Image size 367x367. Mydriatic. Fundus image cropped to the optic disc:
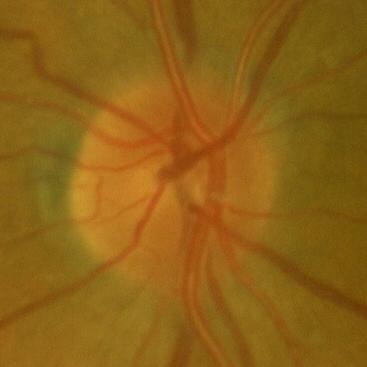 Finding: no glaucomatous optic neuropathy.